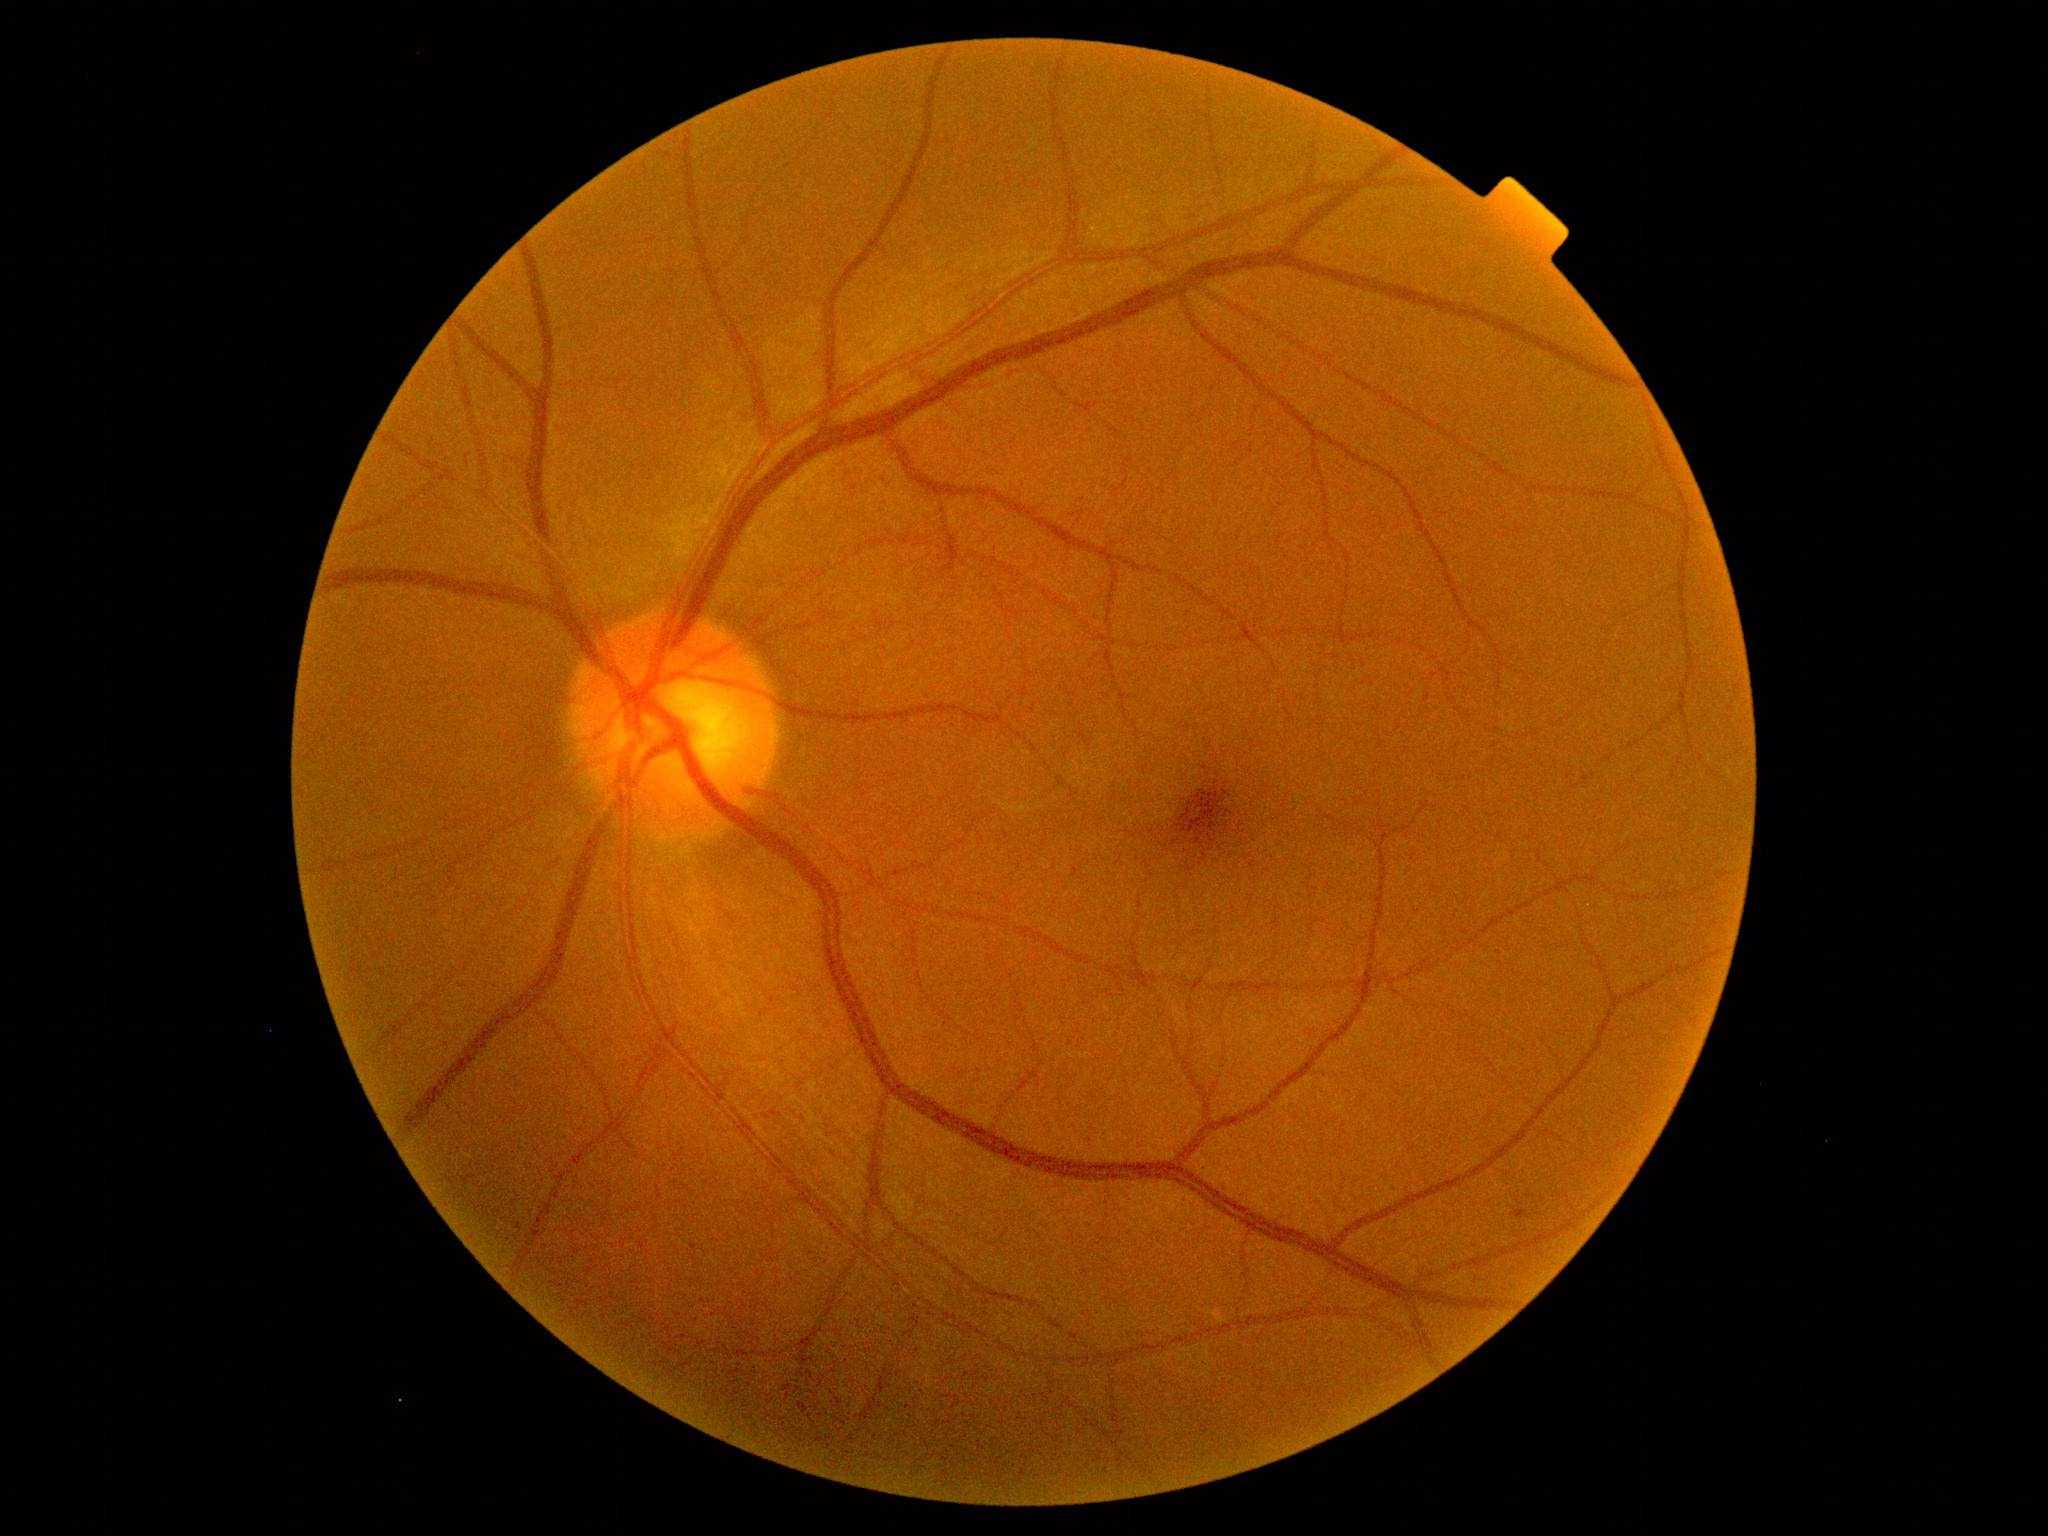
DR stage=1.